512 x 512 pixels; color fundus photograph
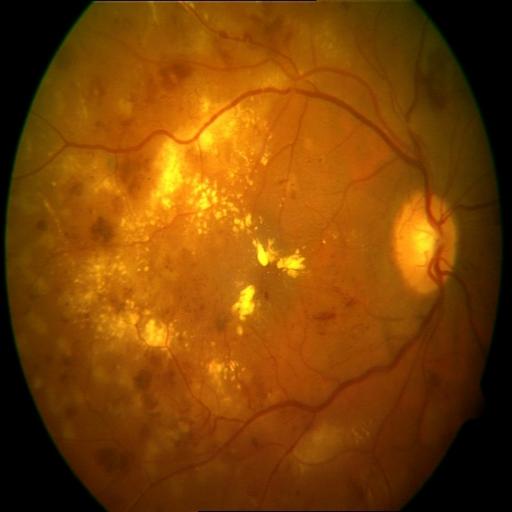 Impression: laser scars | exudation | hemorrhagic retinopathy.